2228 by 1652 pixels:
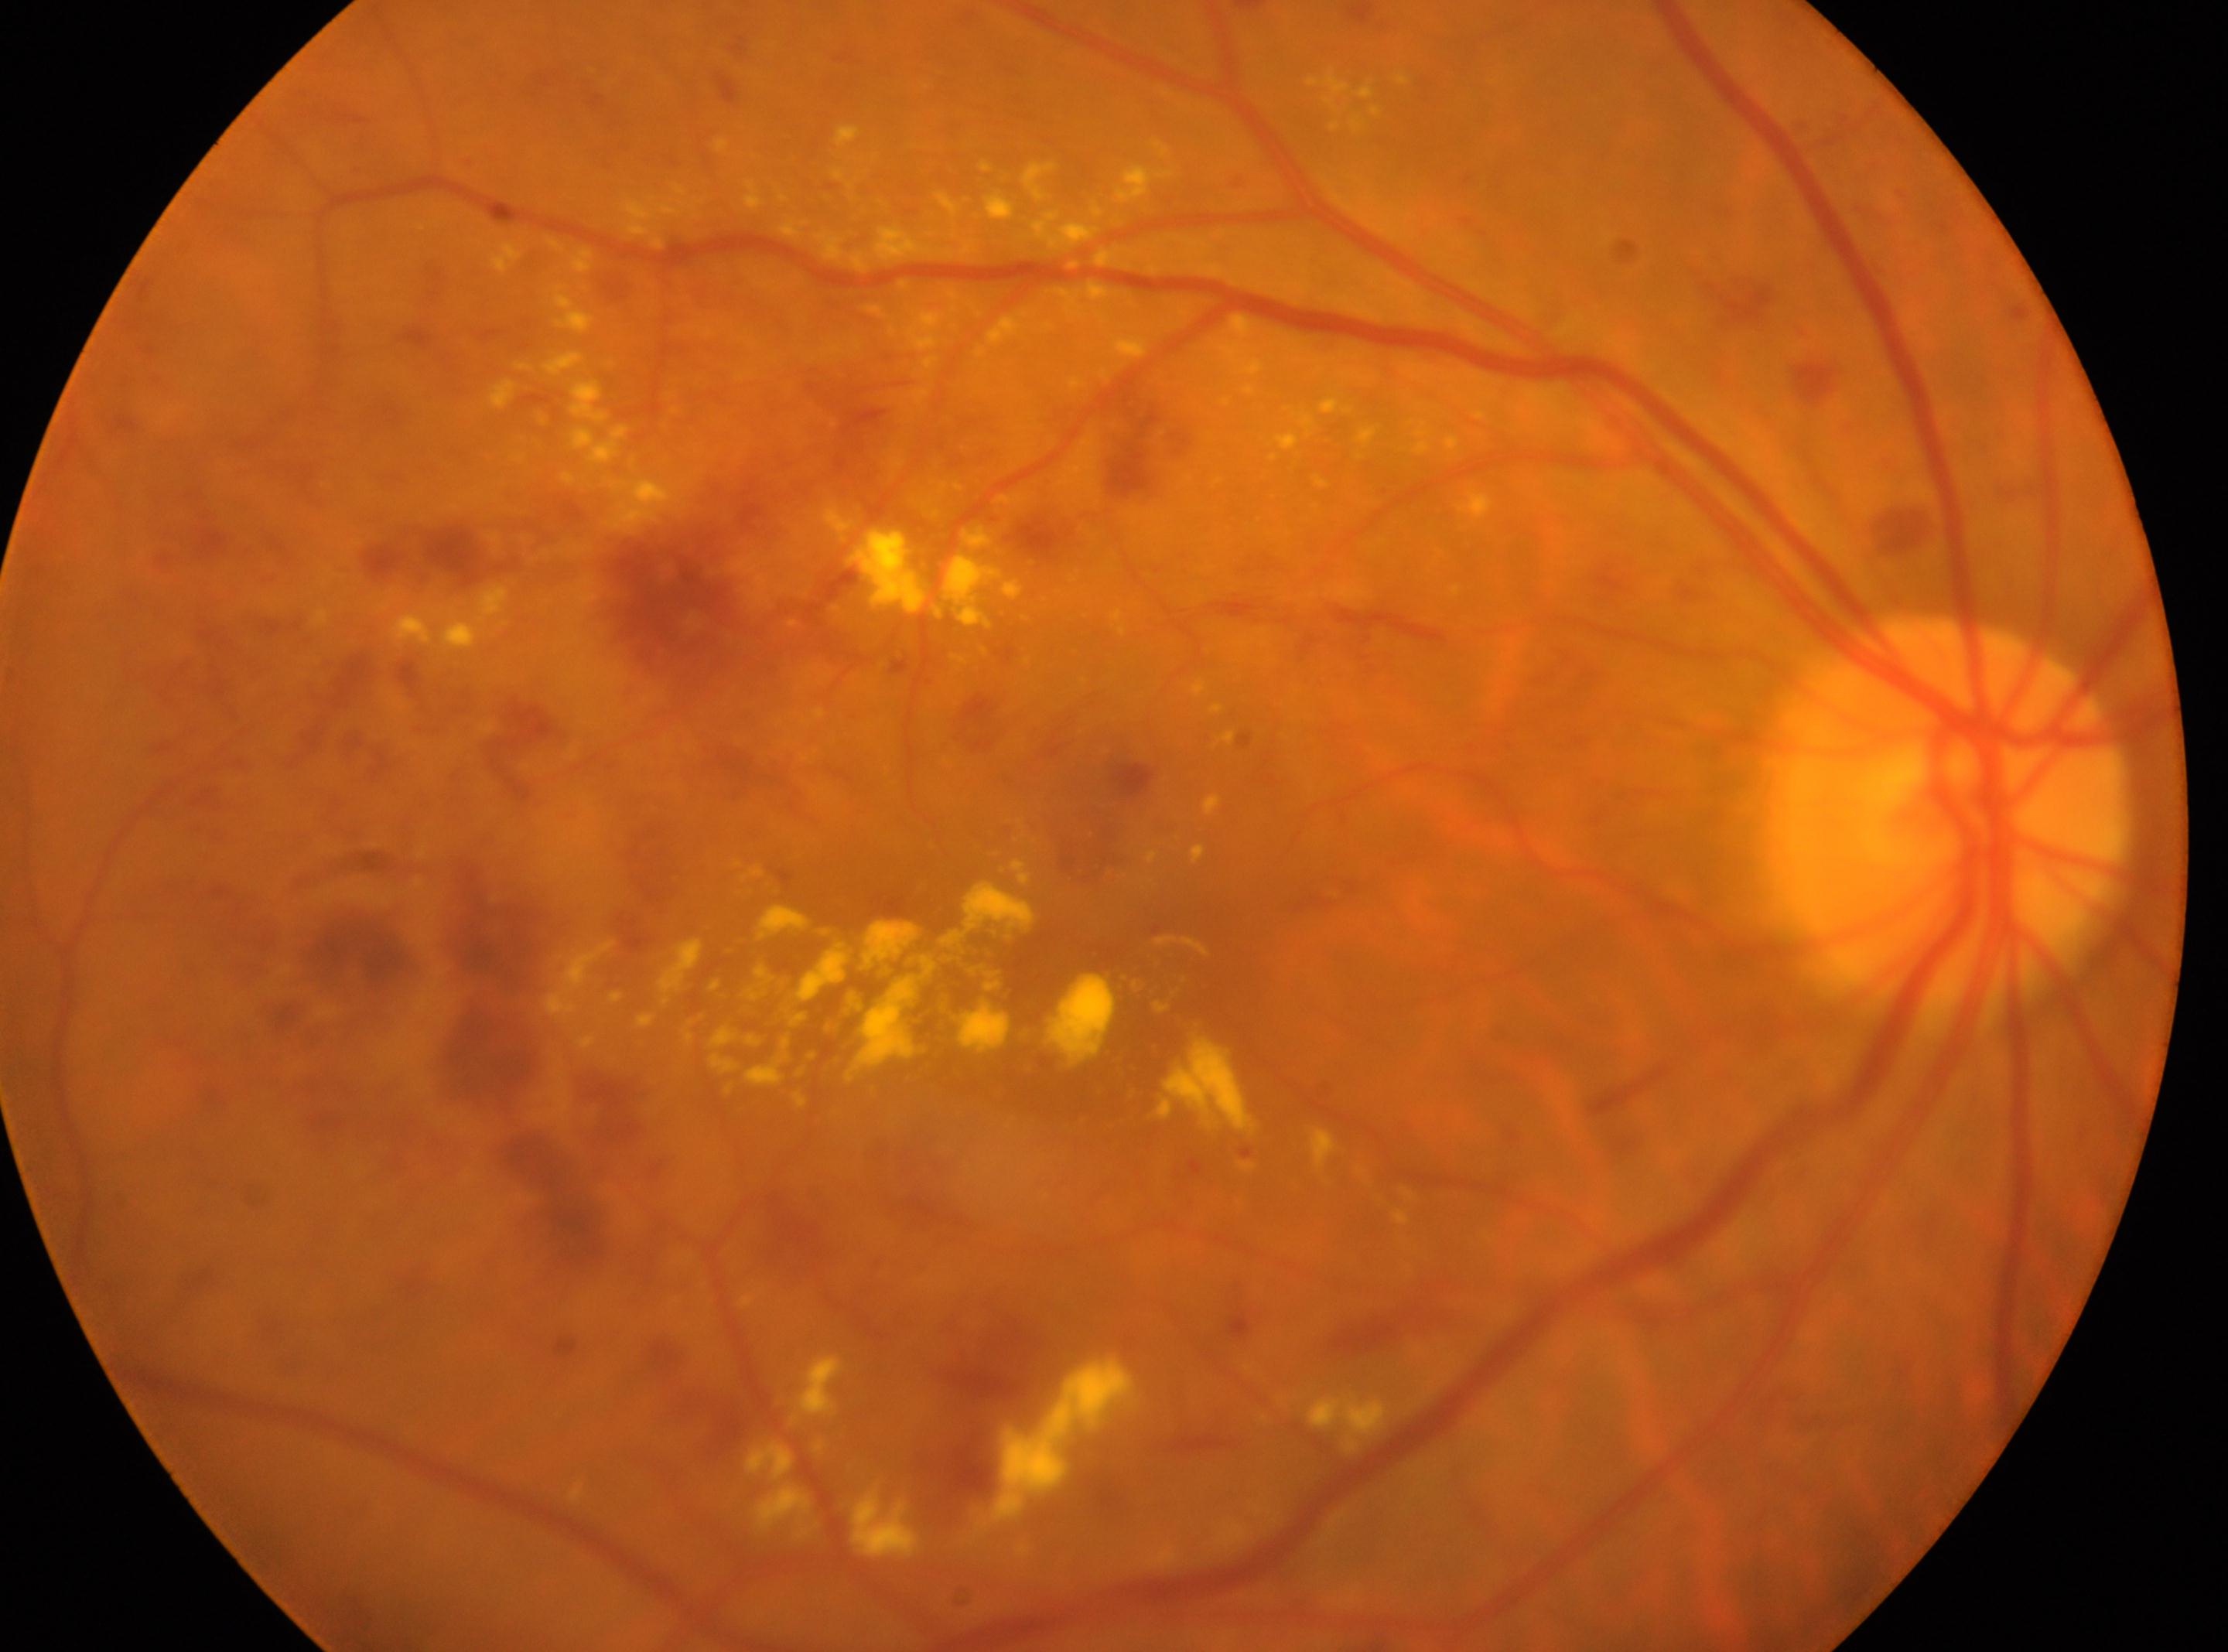

{
  "dr_grade": "3/4",
  "optic_disc": "[1950, 813]",
  "fovea": "[1143, 939]",
  "eye": "right eye"
}